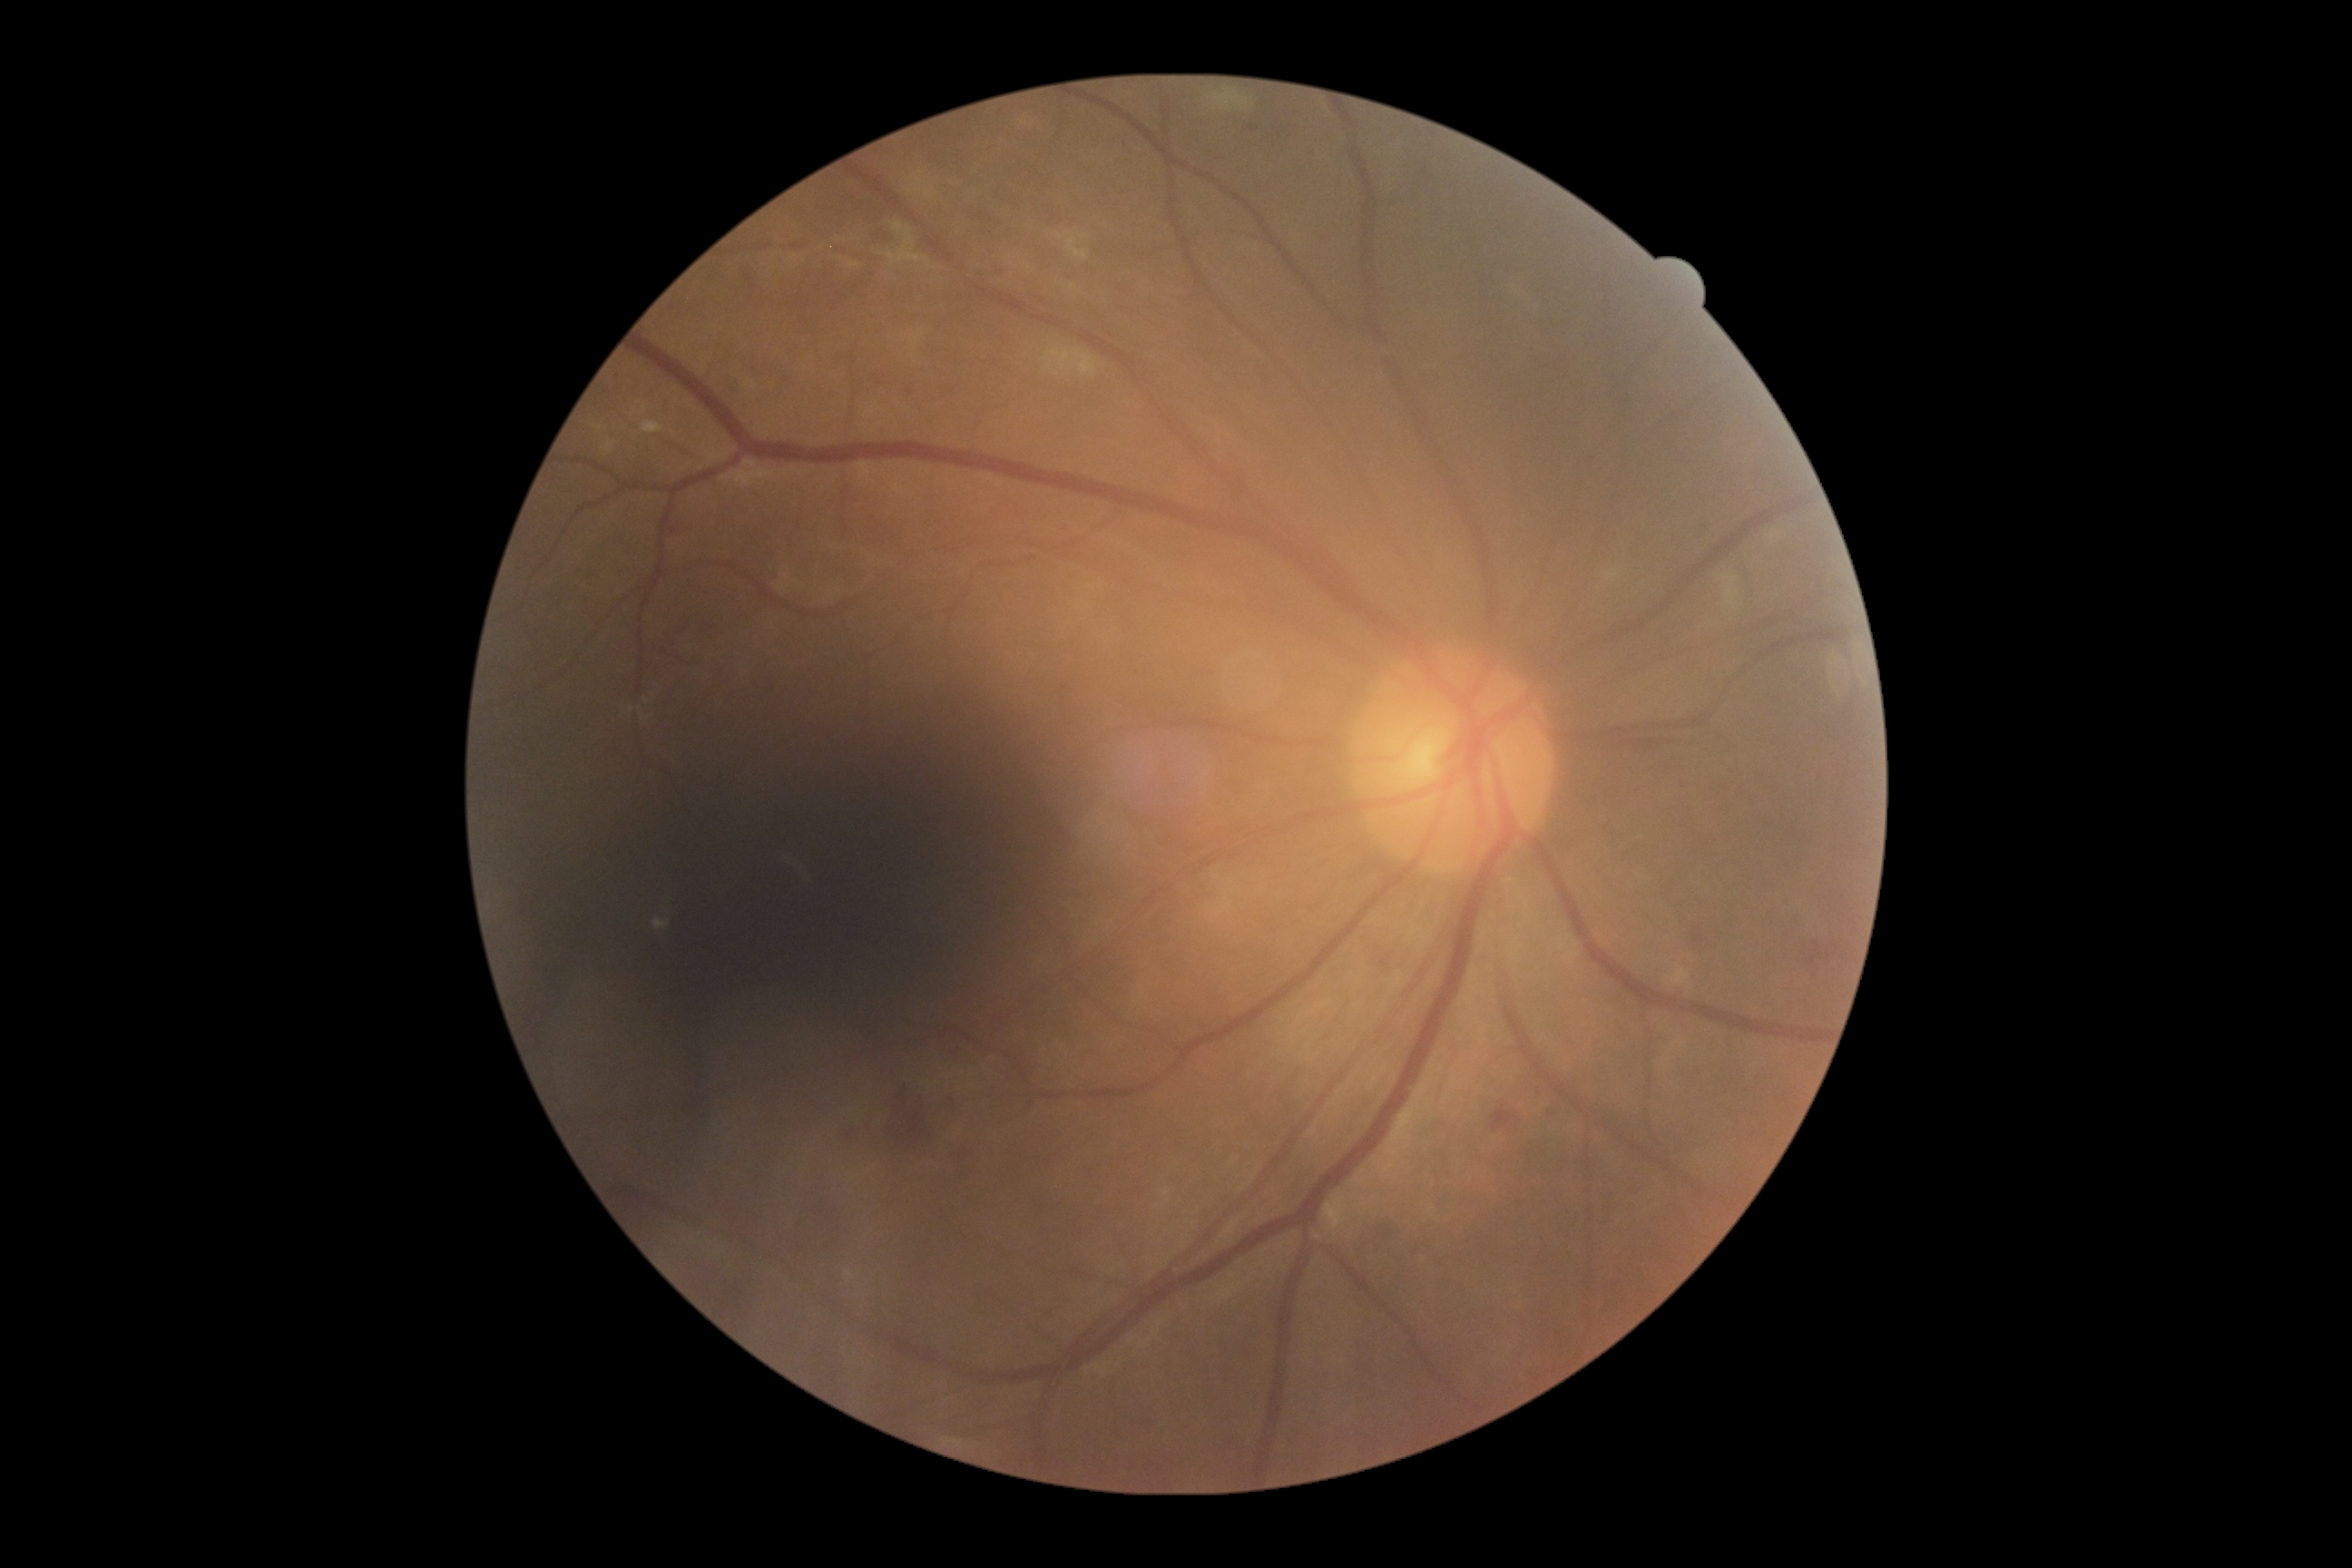 DR = 2.